Fundus photo:
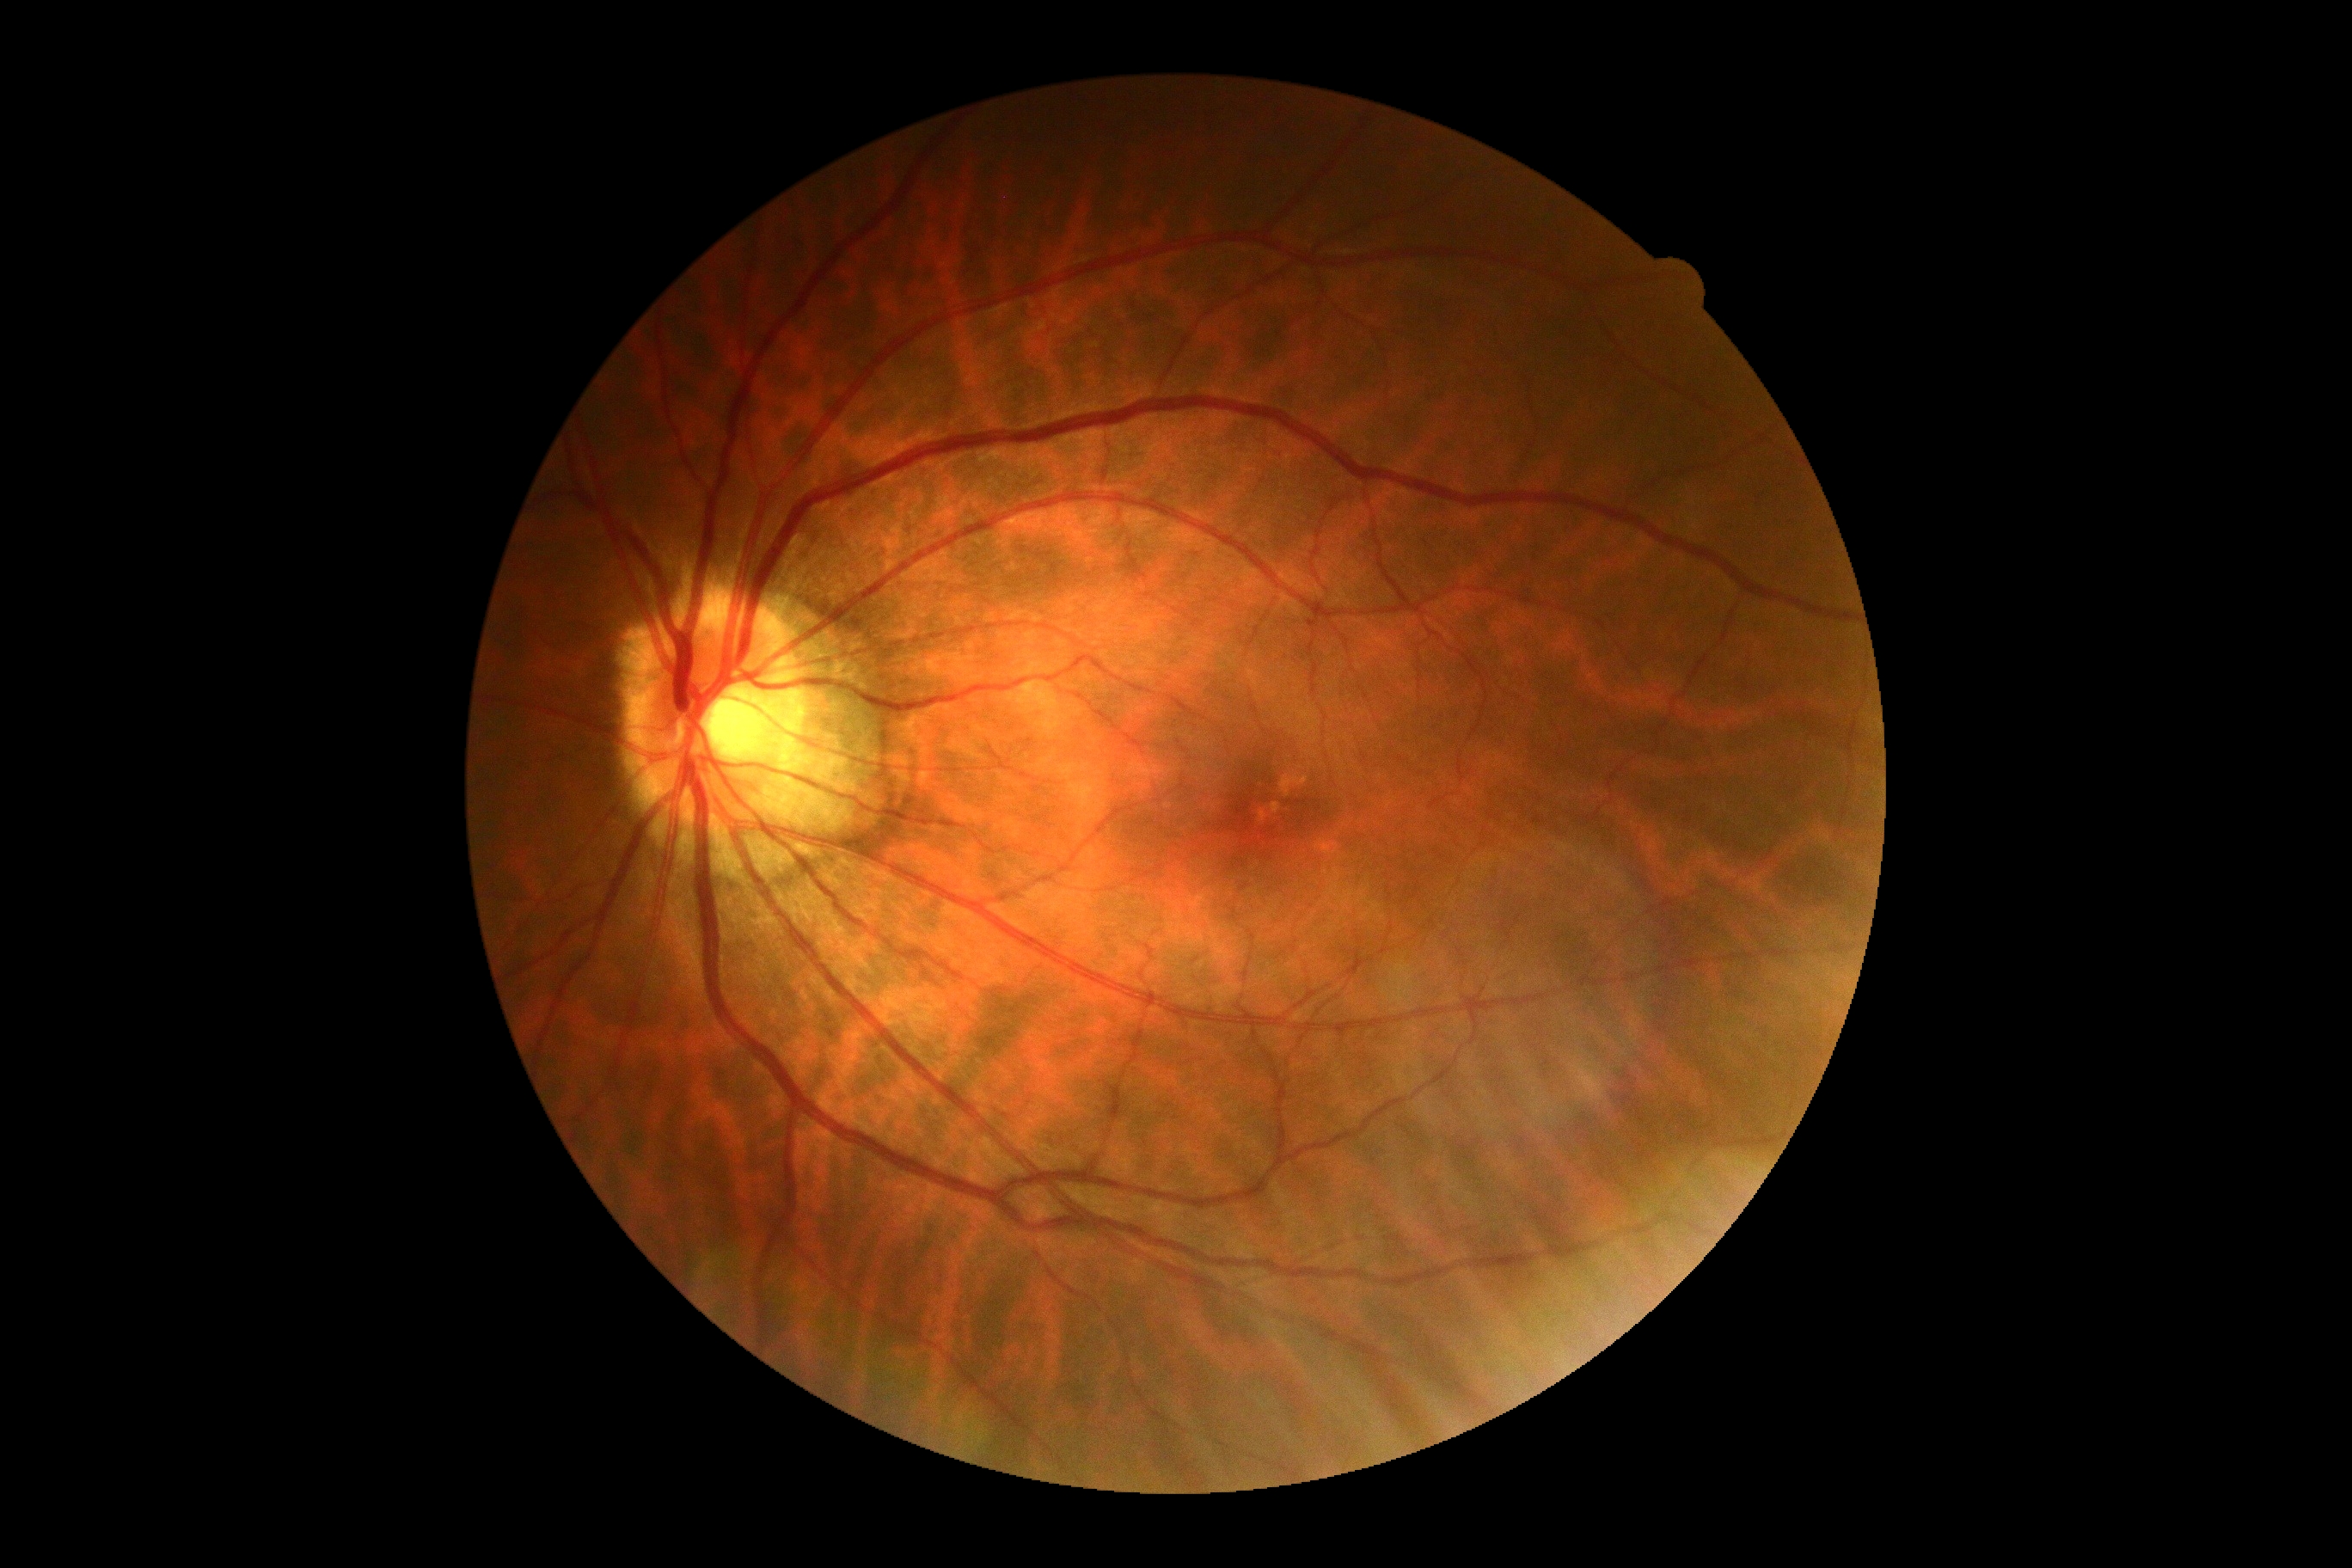
{"dr_grade": "no apparent diabetic retinopathy (0)", "dr_impression": "negative for DR"}